Non-mydriatic acquisition
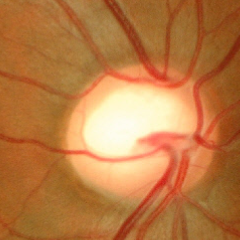
No glaucomatous findings.